DR severity per modified Davis staging:
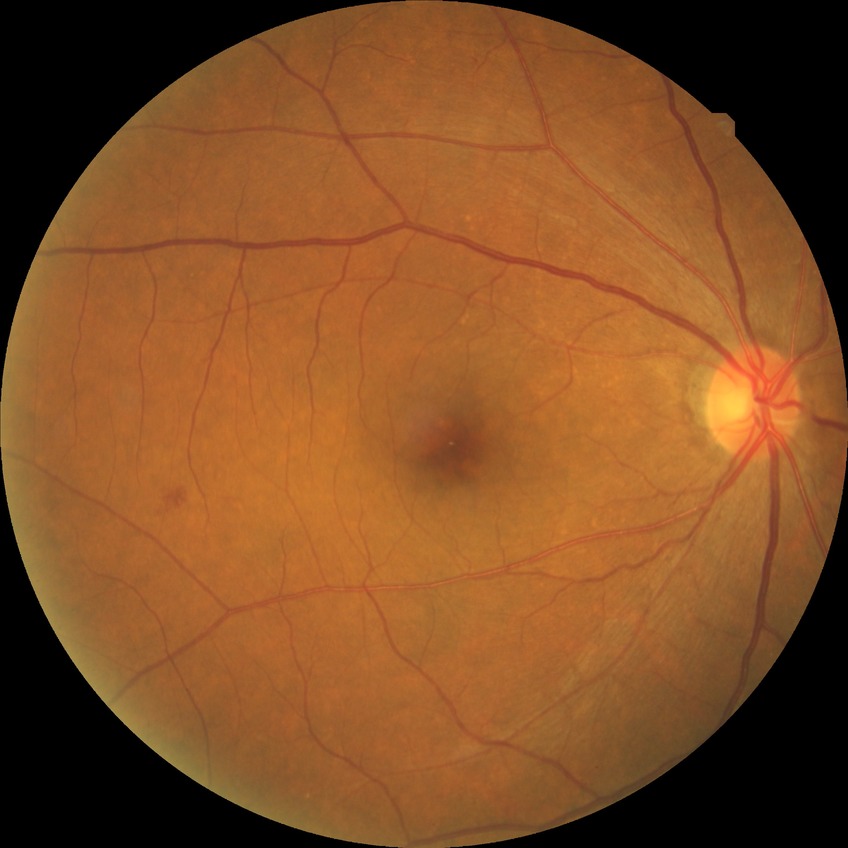

Davis stage is SDR.
Disease class: non-proliferative diabetic retinopathy.